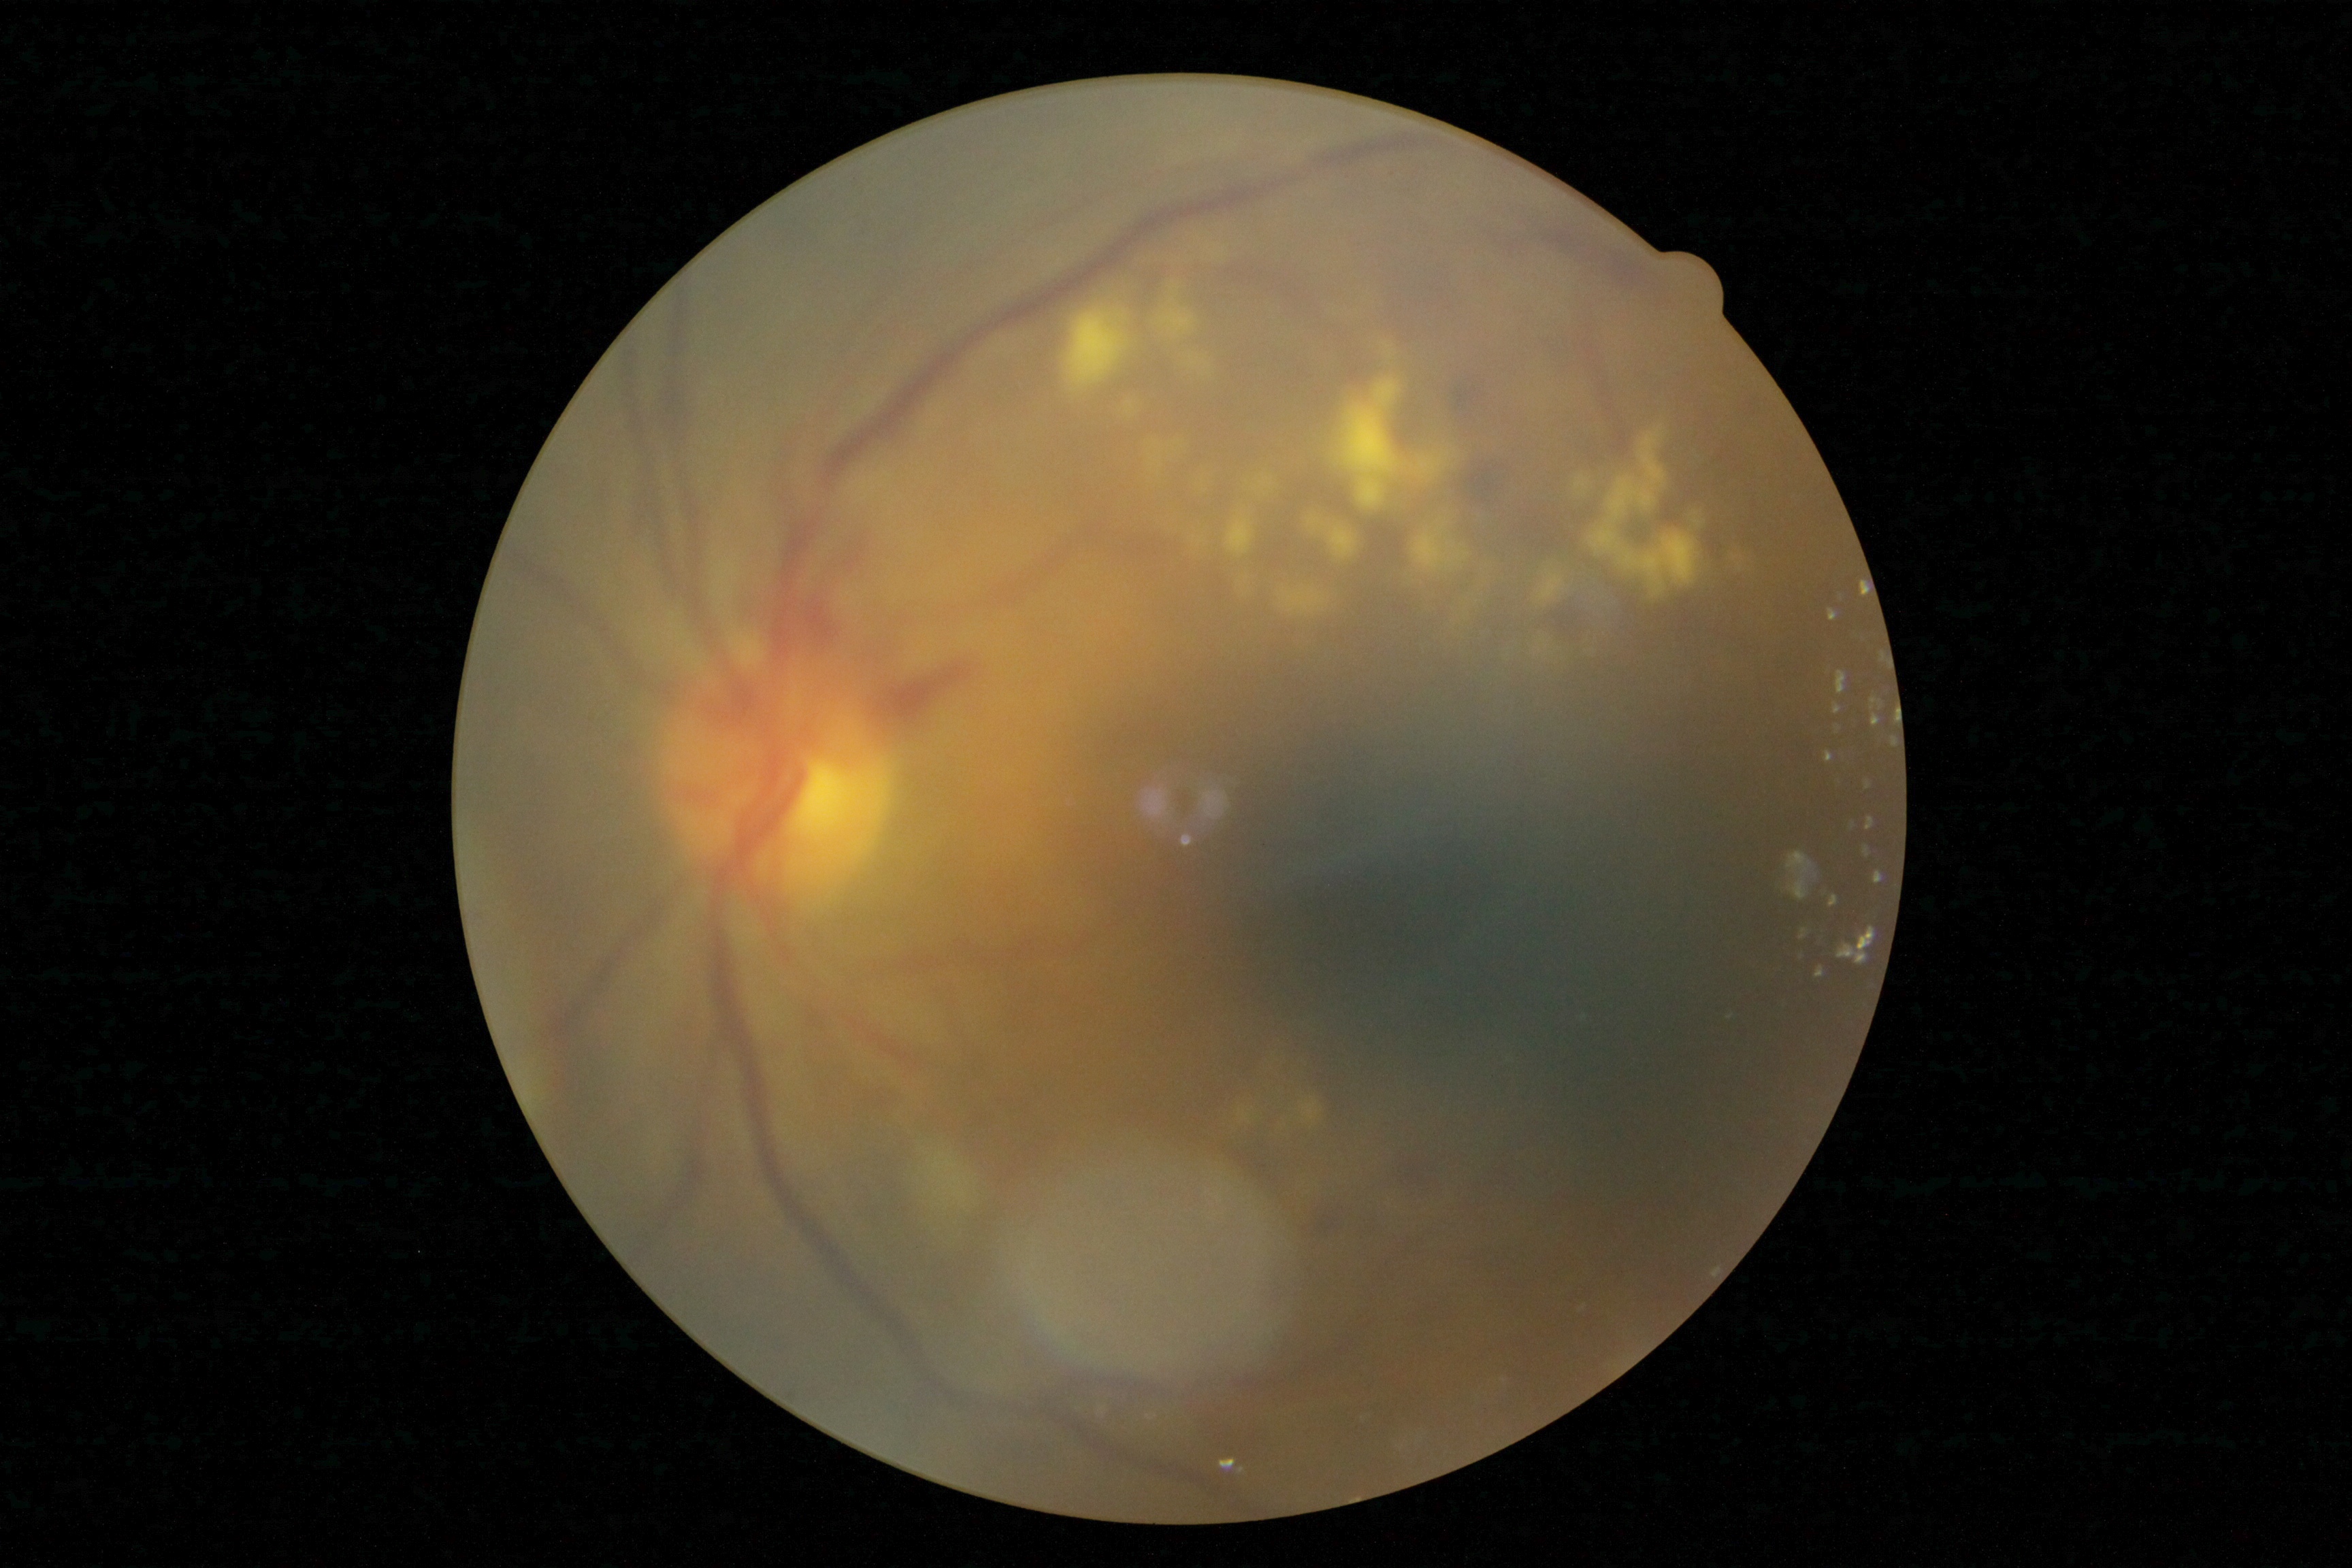 Retinopathy grade: 2.